Pediatric retinal photograph (wide-field) · acquired on the Natus RetCam Envision:
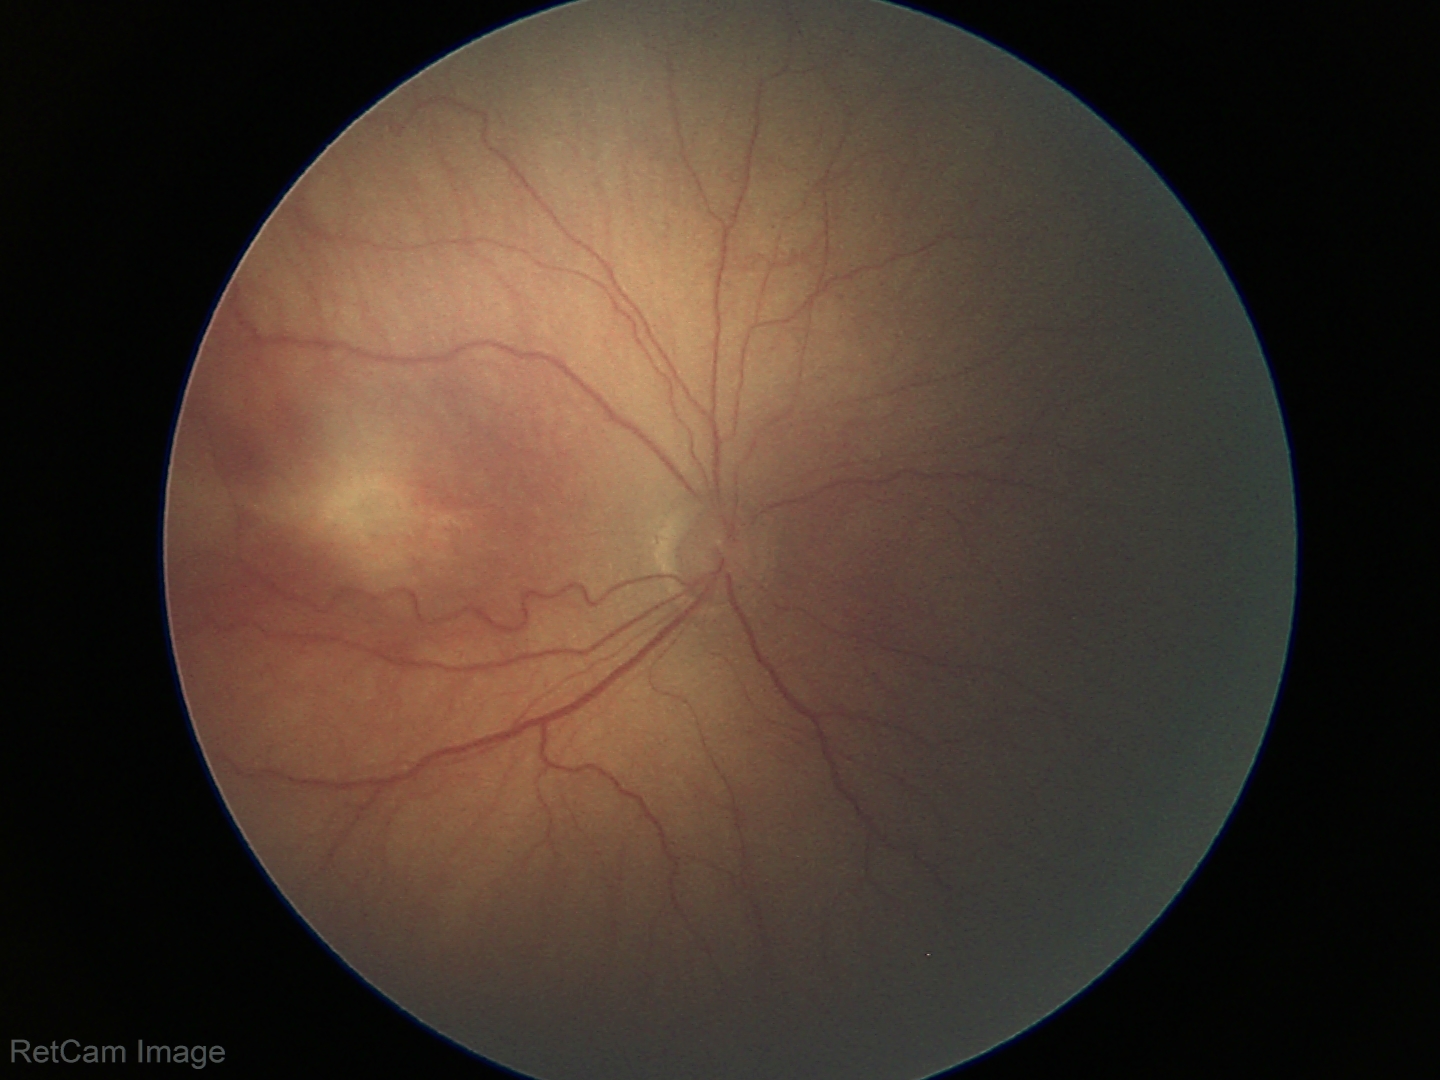
Without plus disease.
Examination diagnosed as retinopathy of prematurity stage 3.